Color fundus photograph. Image size 2352x1568:
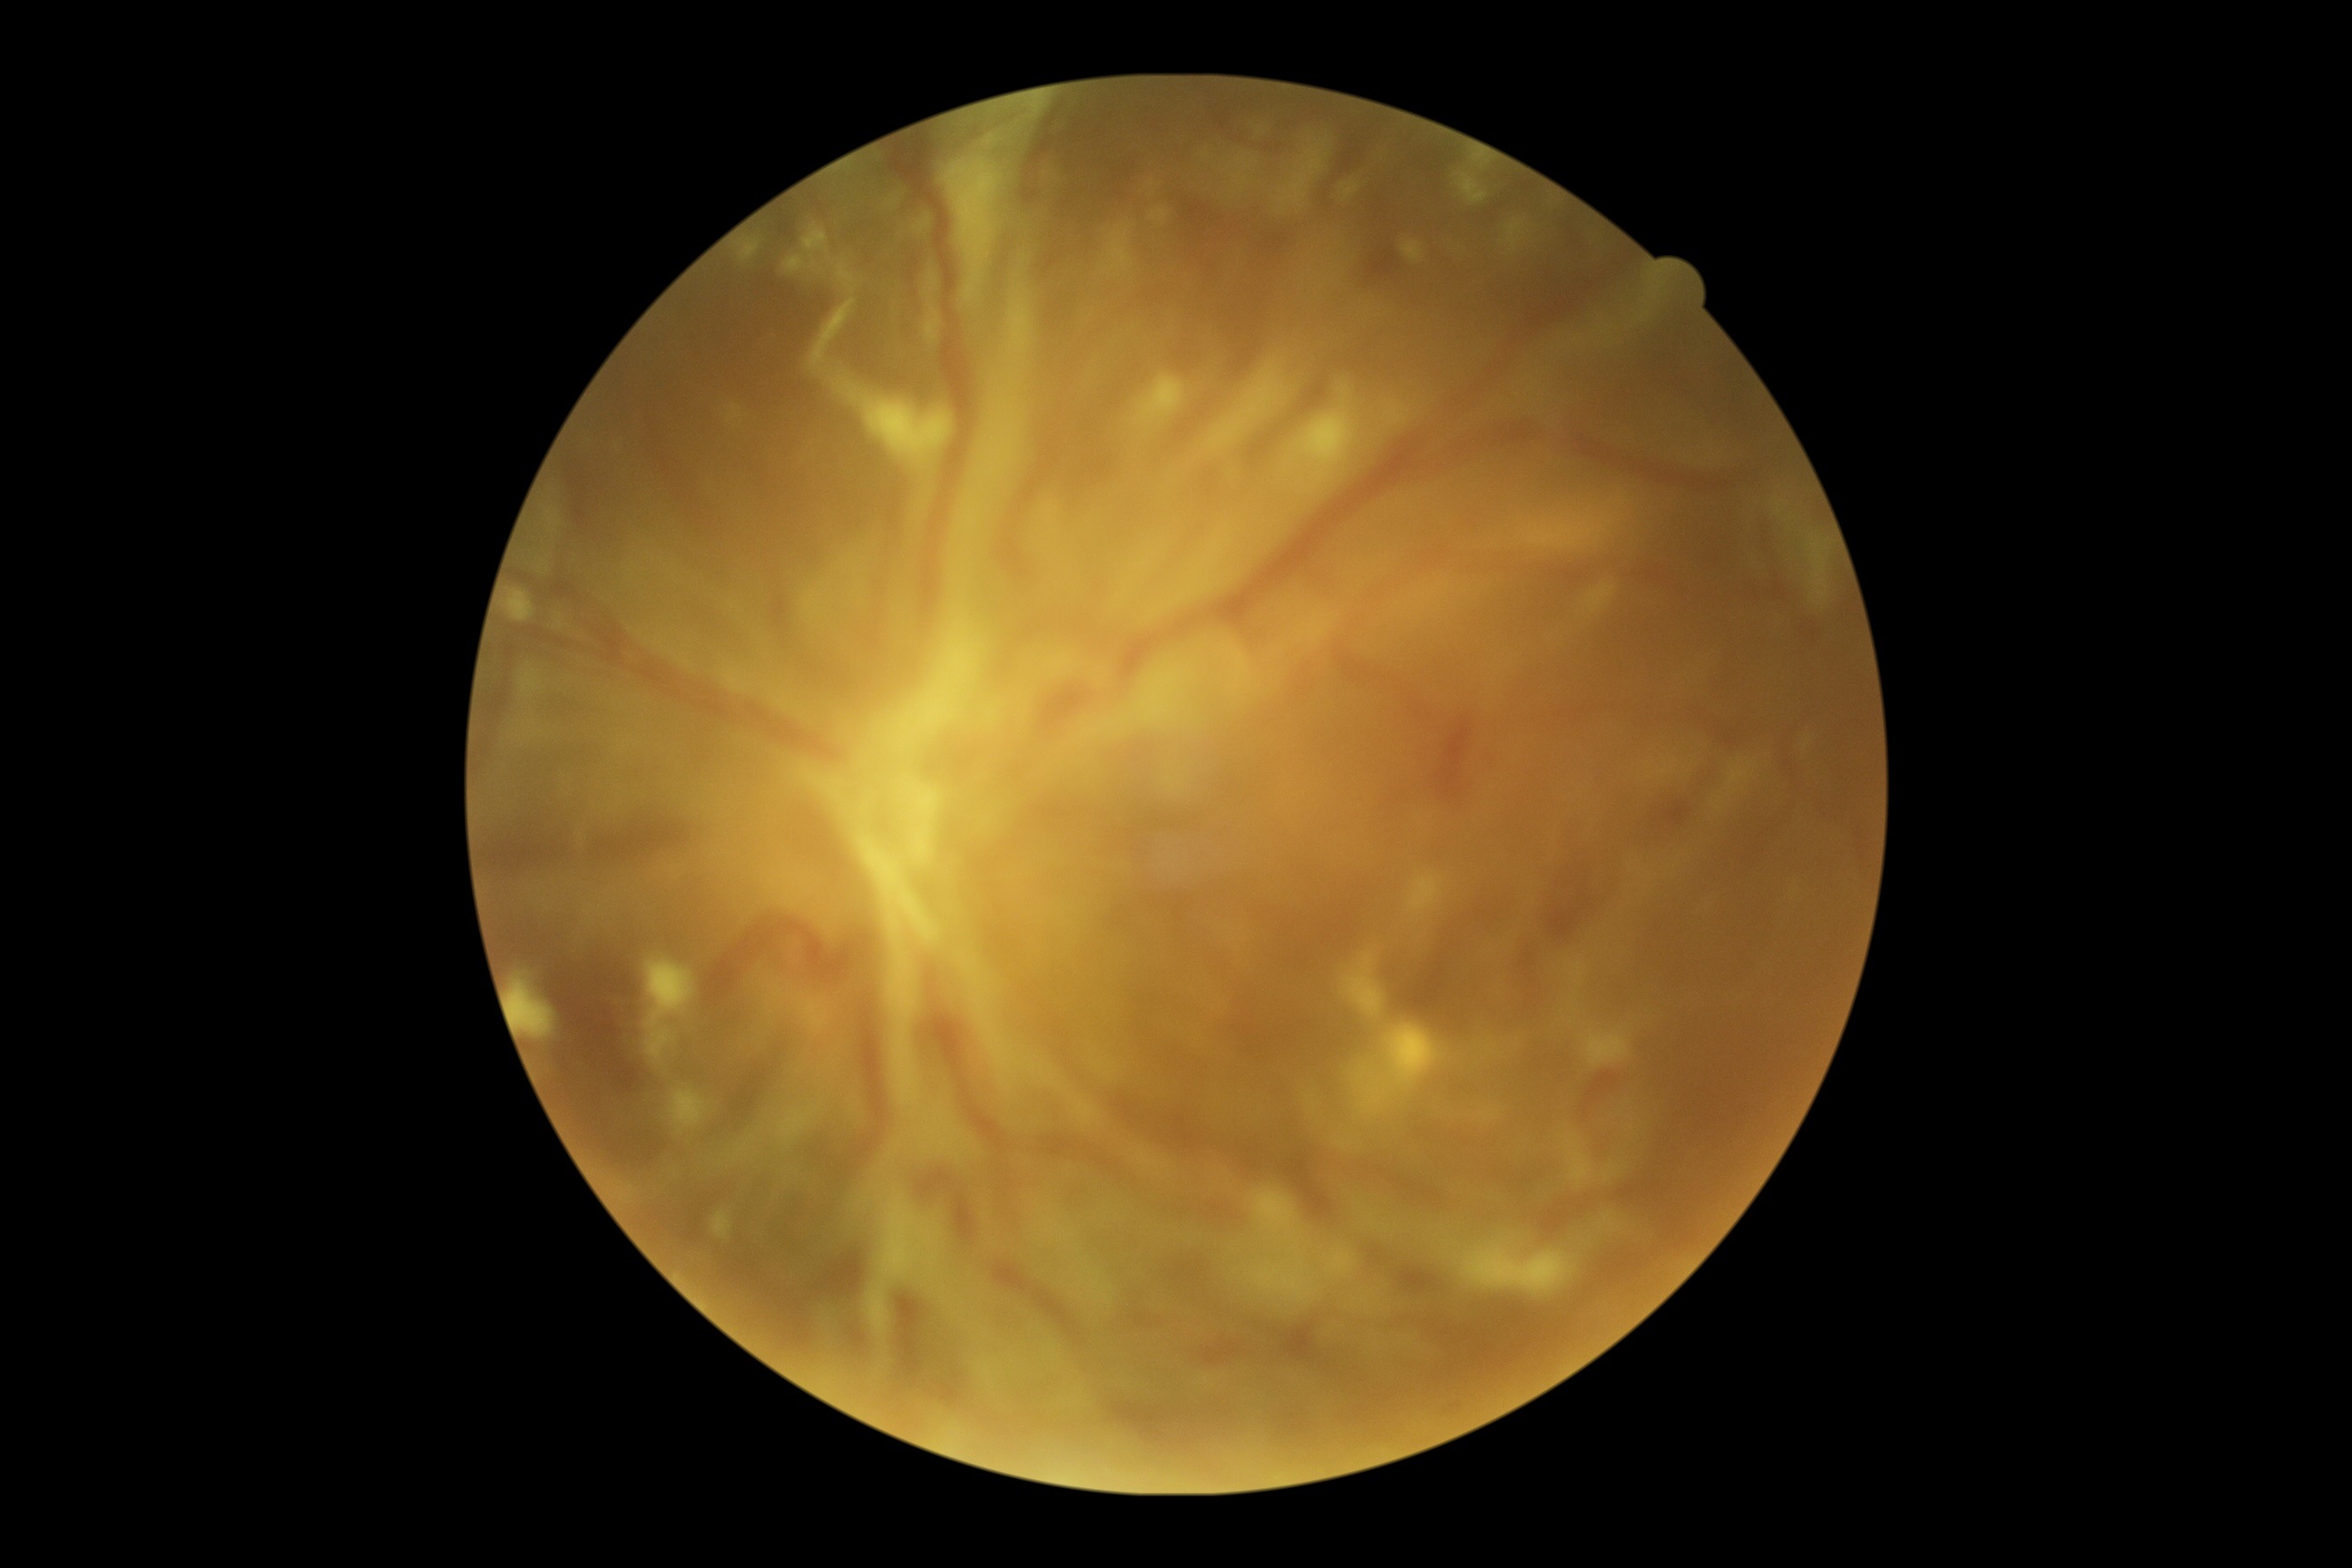

diabetic retinopathy = grade 4.